45-degree field of view
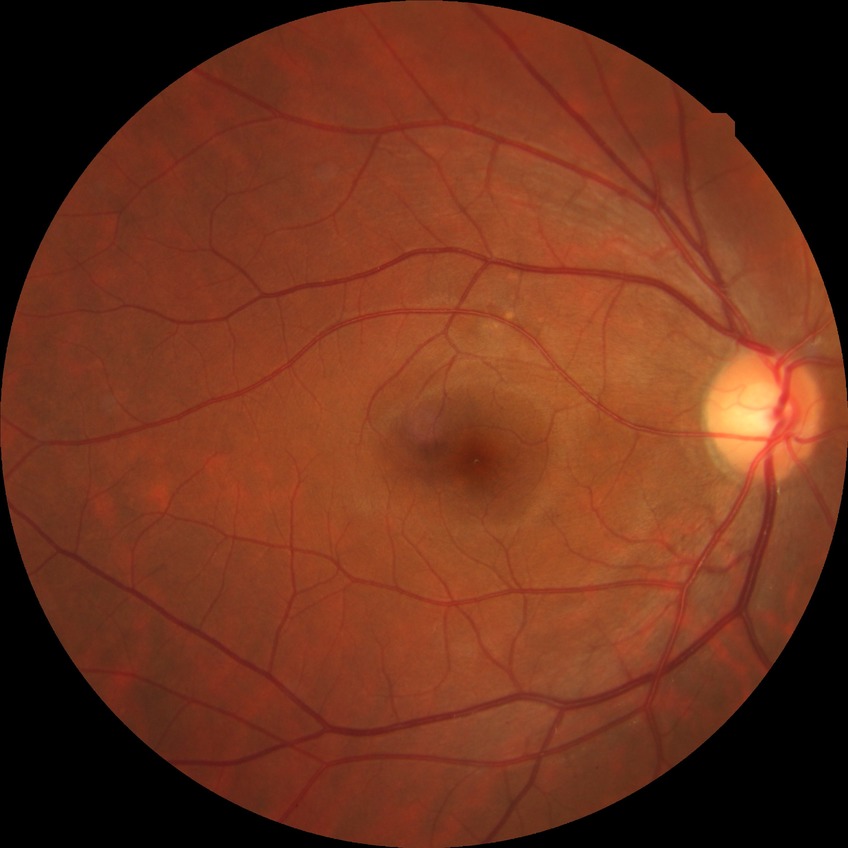
diabetic retinopathy severity: no diabetic retinopathy.